Pediatric wide-field fundus photograph:
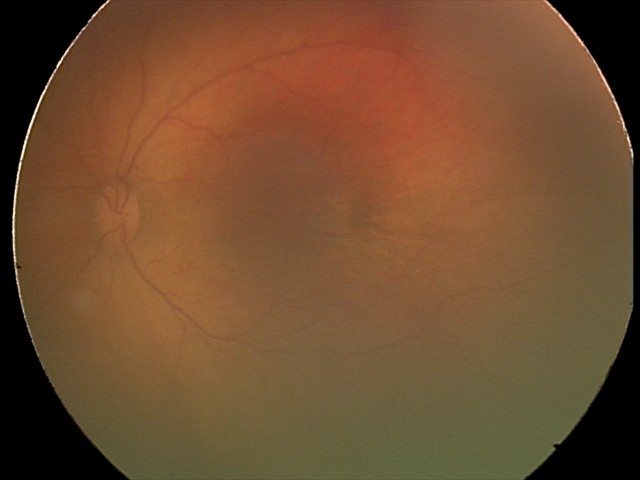
No retinal pathology identified on screening.